45° field of view, 1932x1910px.
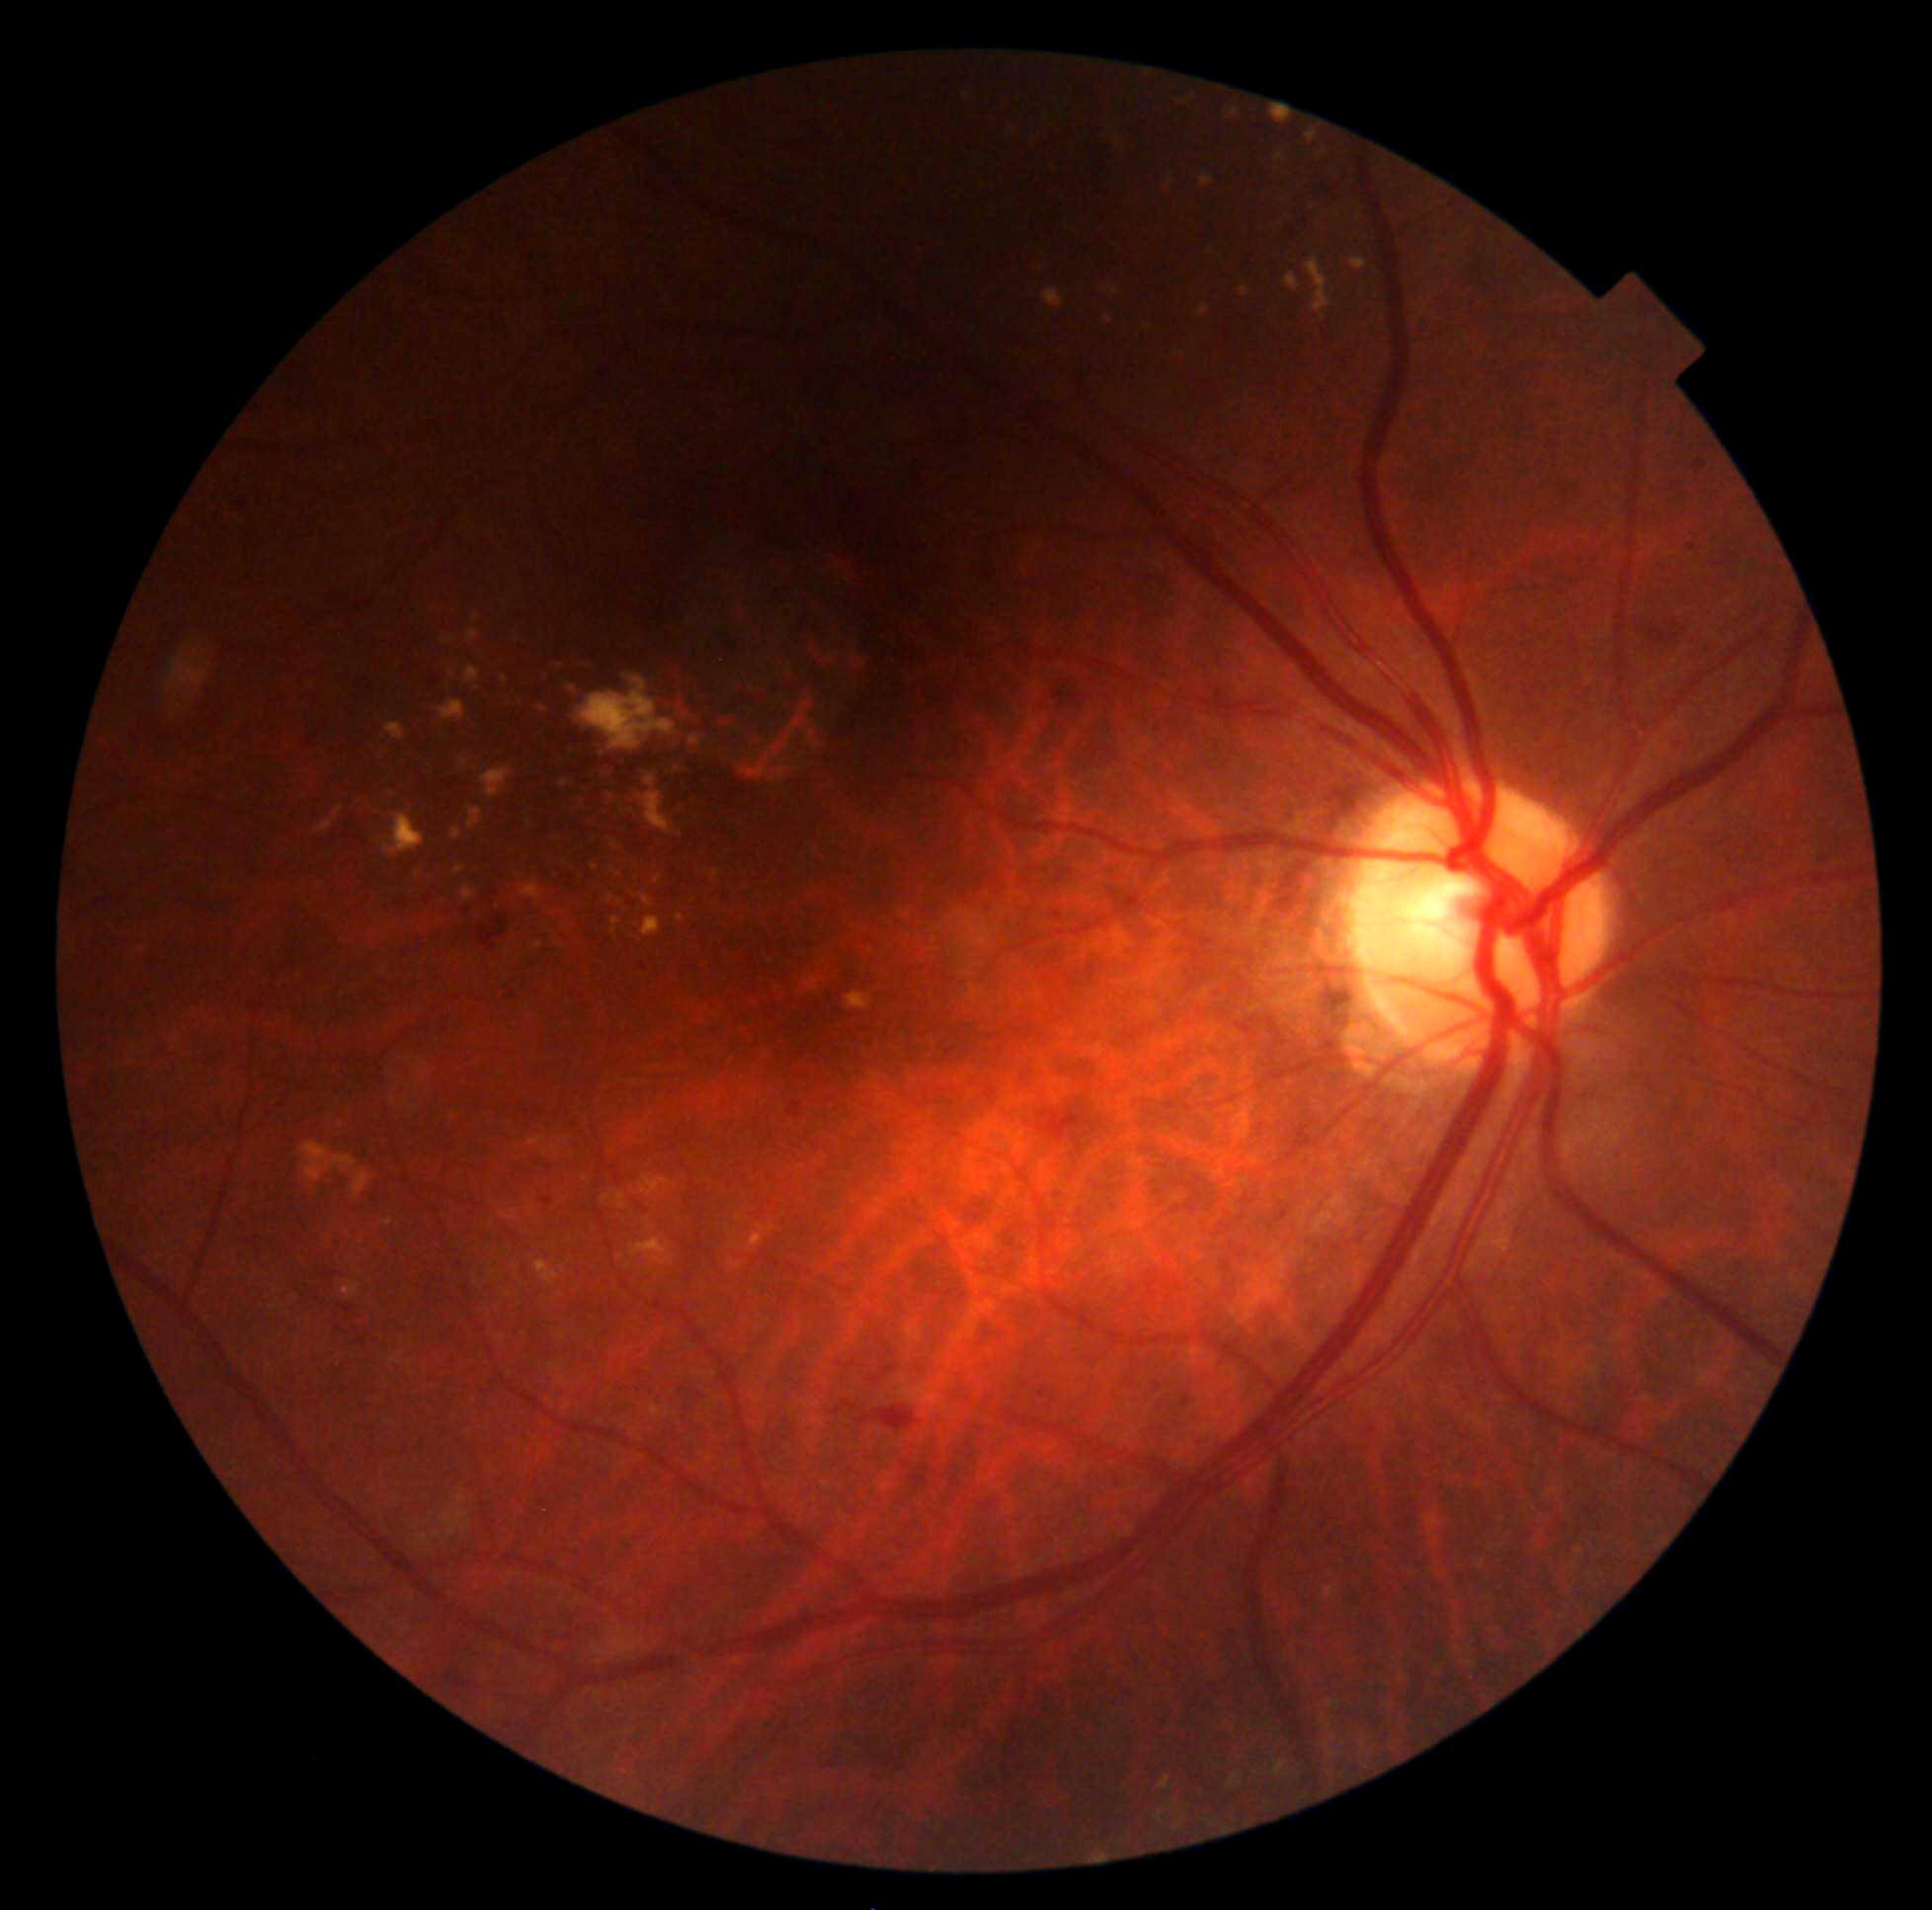 Diabetic retinopathy (DR): 2/4; non-proliferative diabetic retinopathy
Representative lesions:
* soft exudates (SEs): not present
* hard exudates (EXs) (continued): 1202/178/1214/187 | 342/1283/361/1301 | 449/638/457/642 | 1106/285/1117/296 | 592/864/599/872 | 640/1175/673/1196 | 774/767/787/778 | 1284/273/1300/290 | 1200/306/1209/317 | 603/1195/611/1204 | 631/1239/676/1266 | 579/677/676/750 | 473/613/480/622 | 440/701/466/721 | 616/1193/627/1209 | 642/916/662/938
* Small EXs approximately at x=507, y=951 | x=802, y=712 | x=452, y=672 | x=628, y=1267
* hemorrhages (HEs): 859/1415/873/1428 | 875/1406/924/1433 | 1650/619/1688/646
* microaneurysms (MAs): not present